45-degree field of view
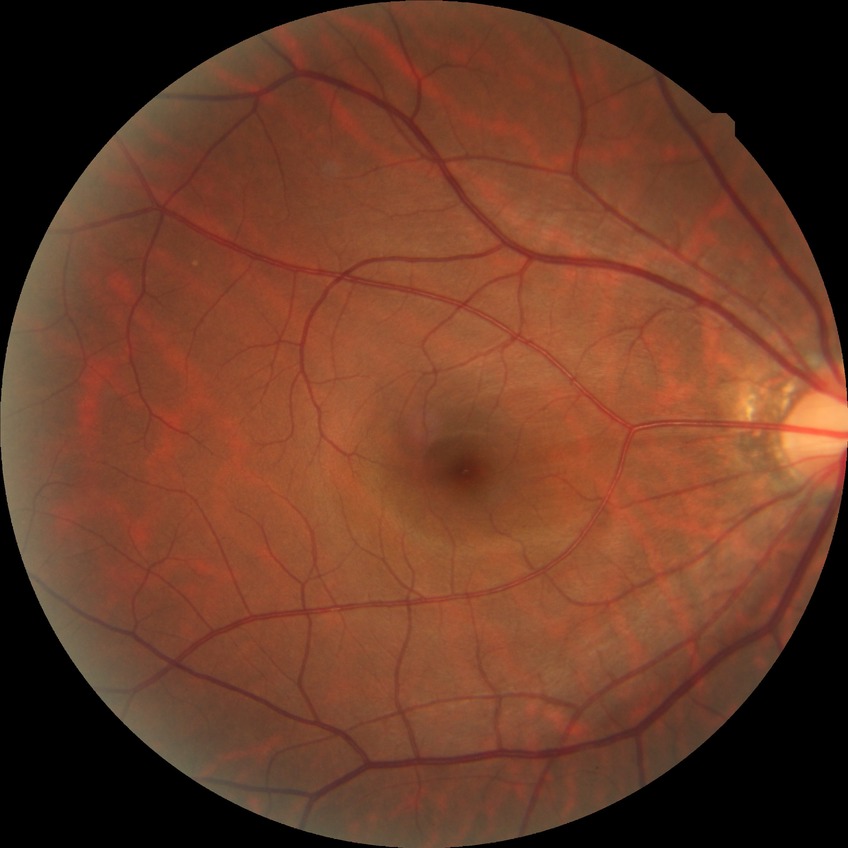 Annotations:
• diabetic retinopathy (DR) — no diabetic retinopathy (NDR)